2048x1536: 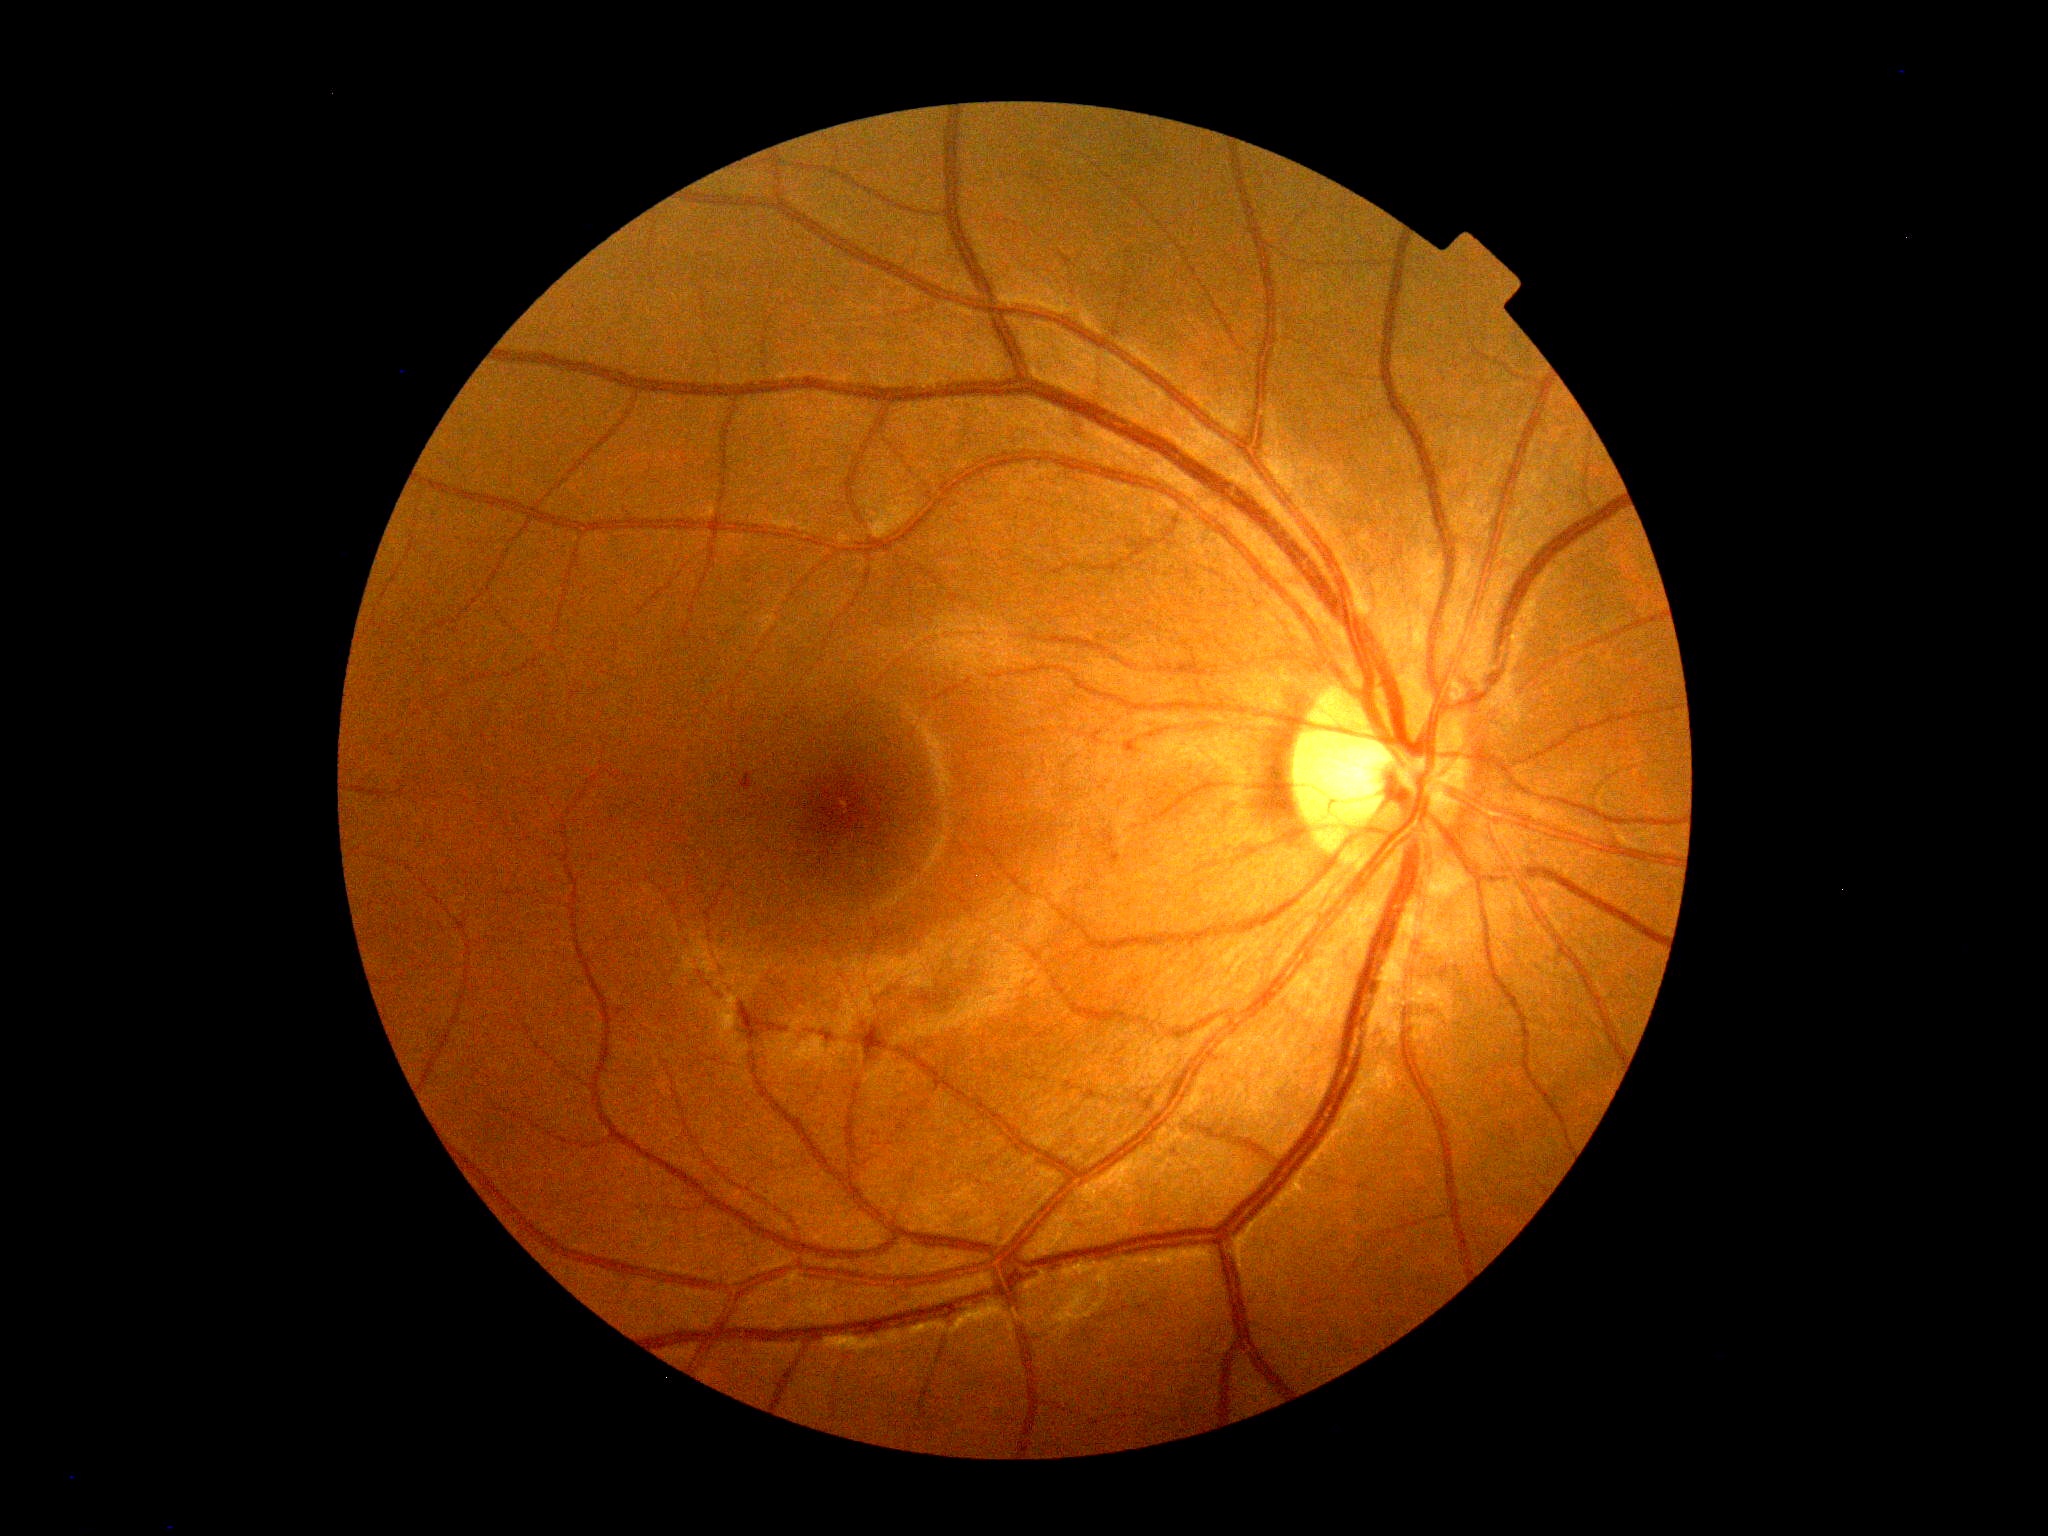
• DR grade: 1 (mild NPDR)